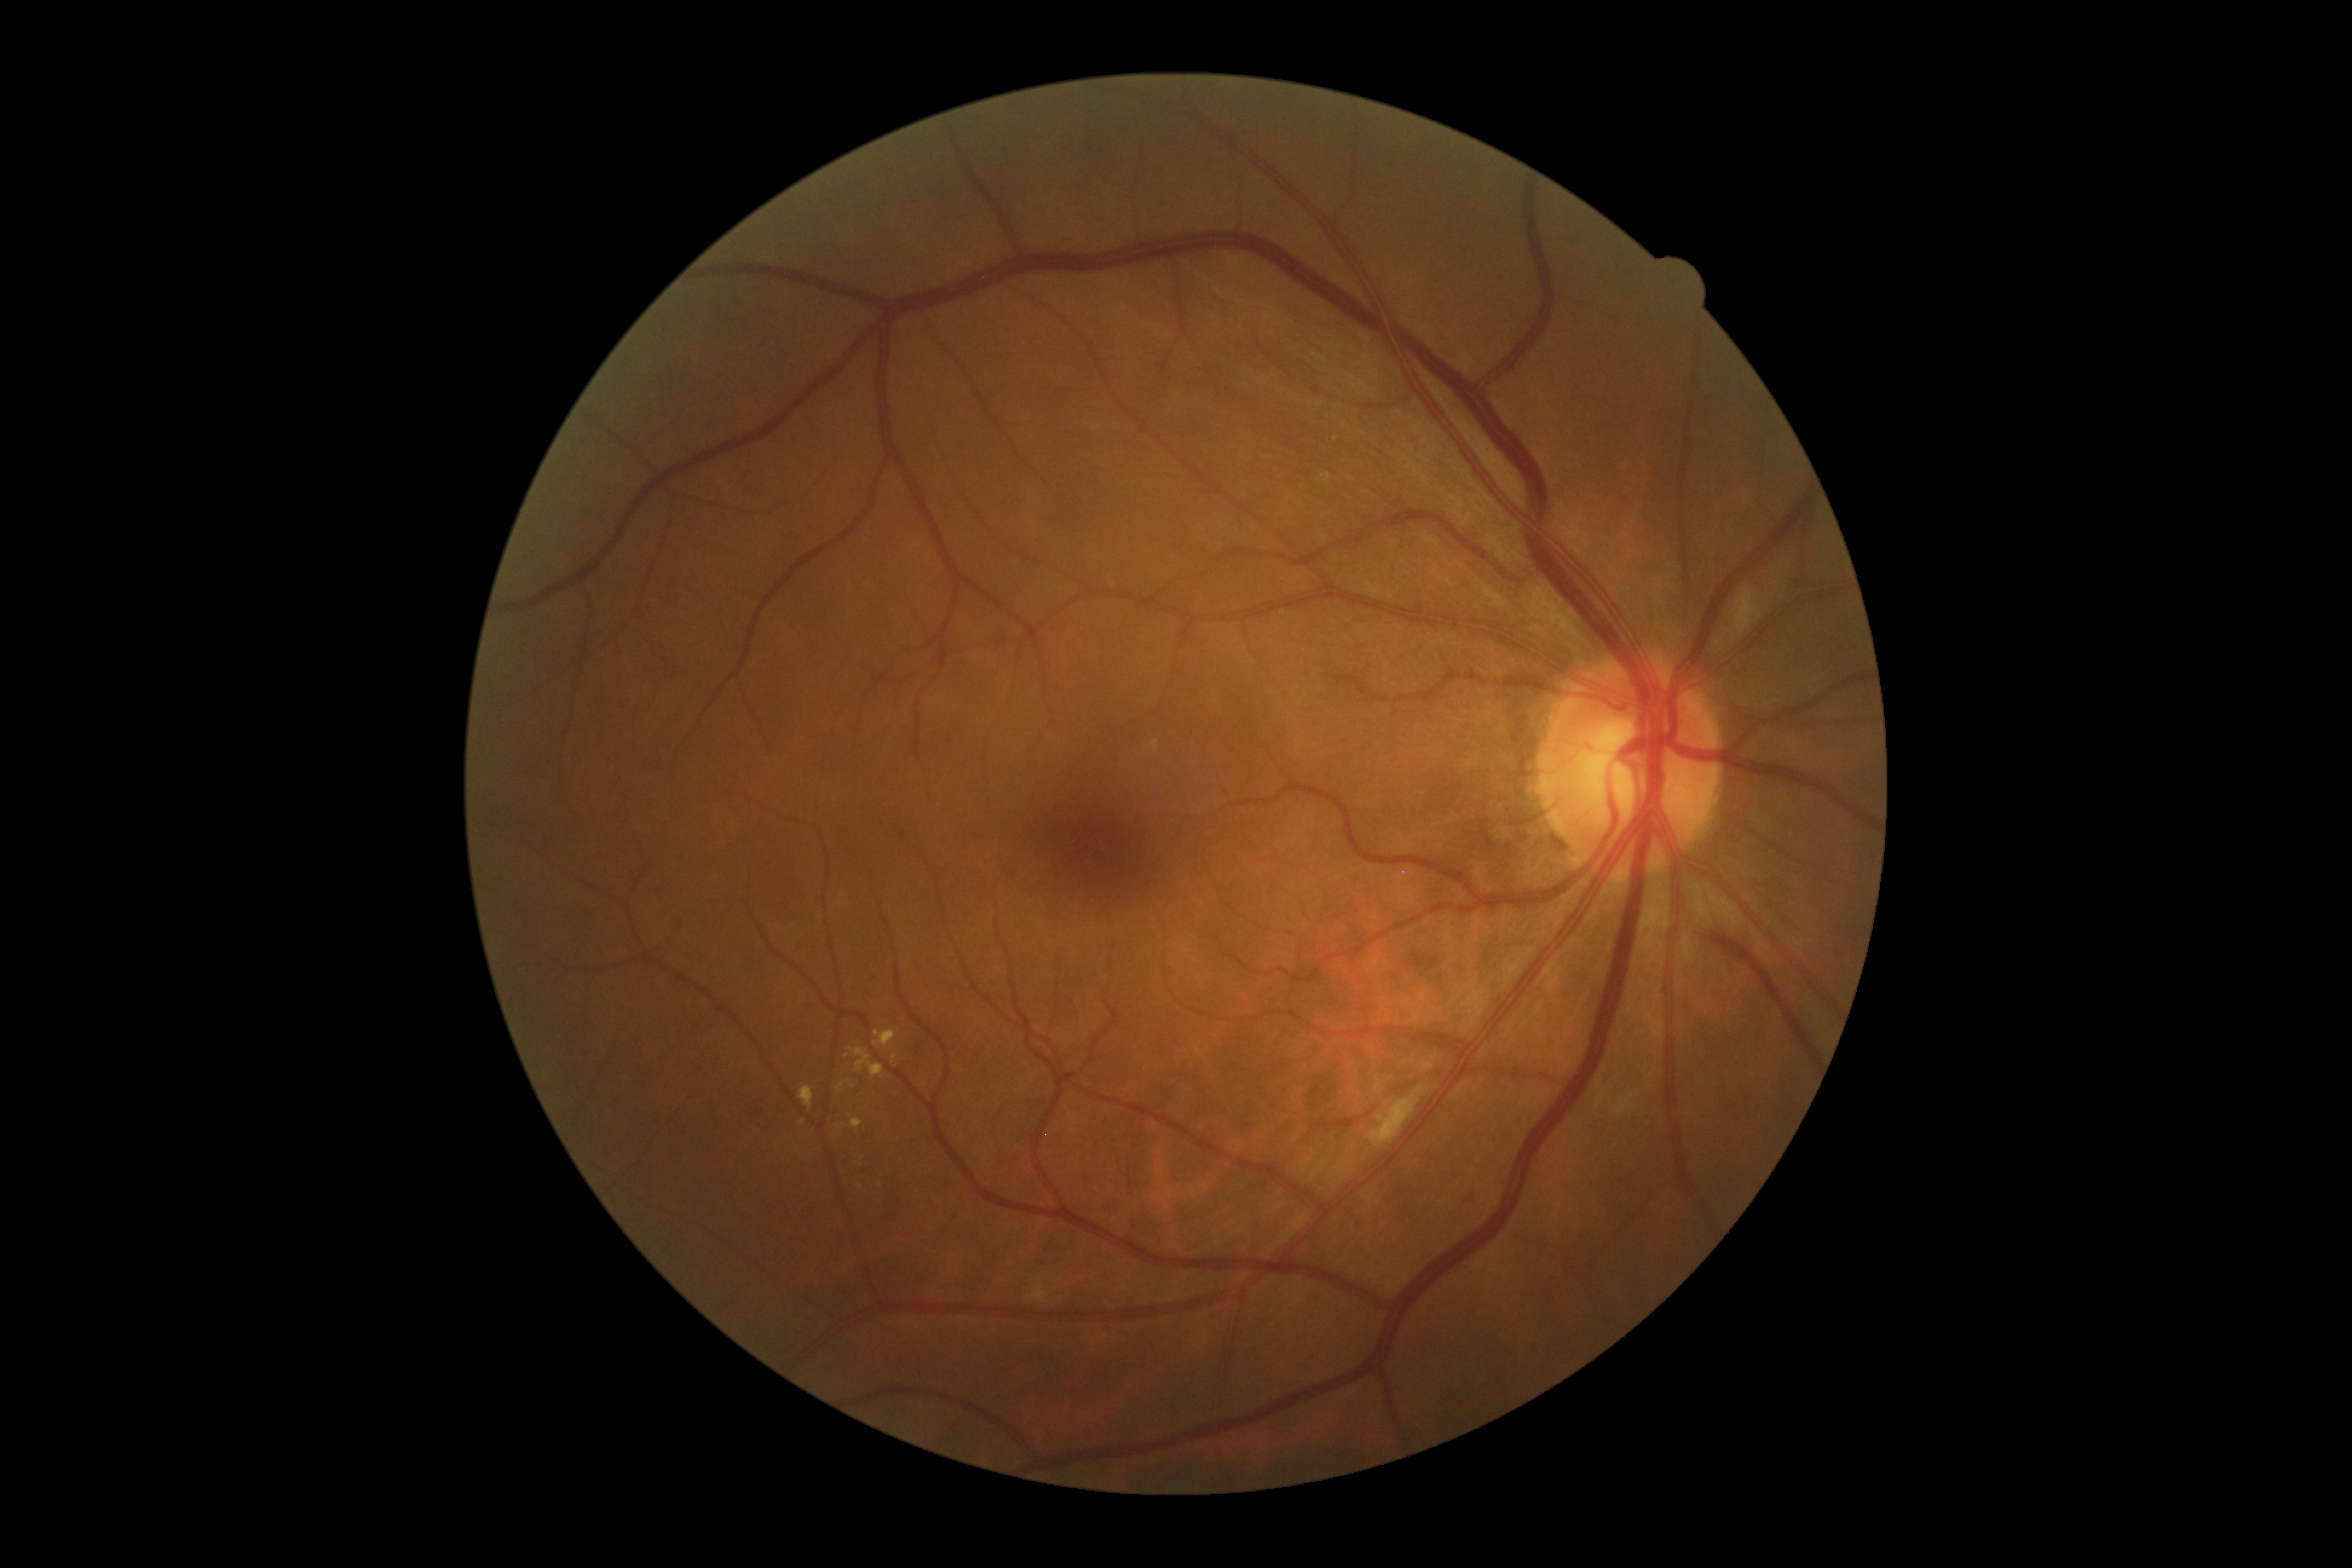
Retinopathy: grade 2 (moderate NPDR) — more than just microaneurysms but less than severe NPDR.